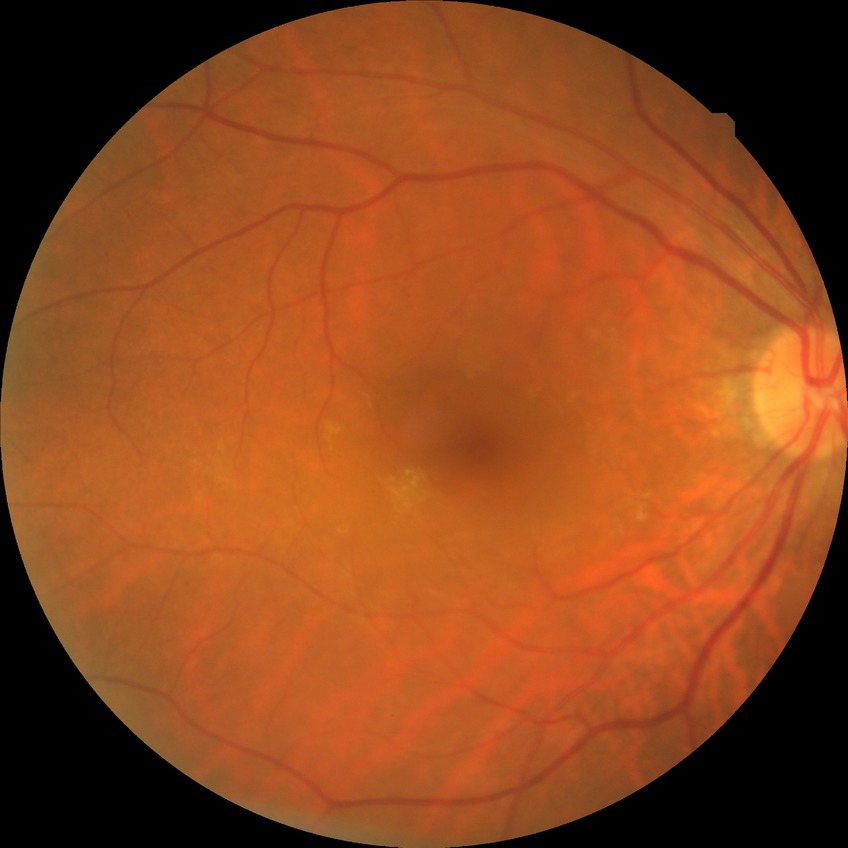

Annotations:
– Davis DR grade: NDR